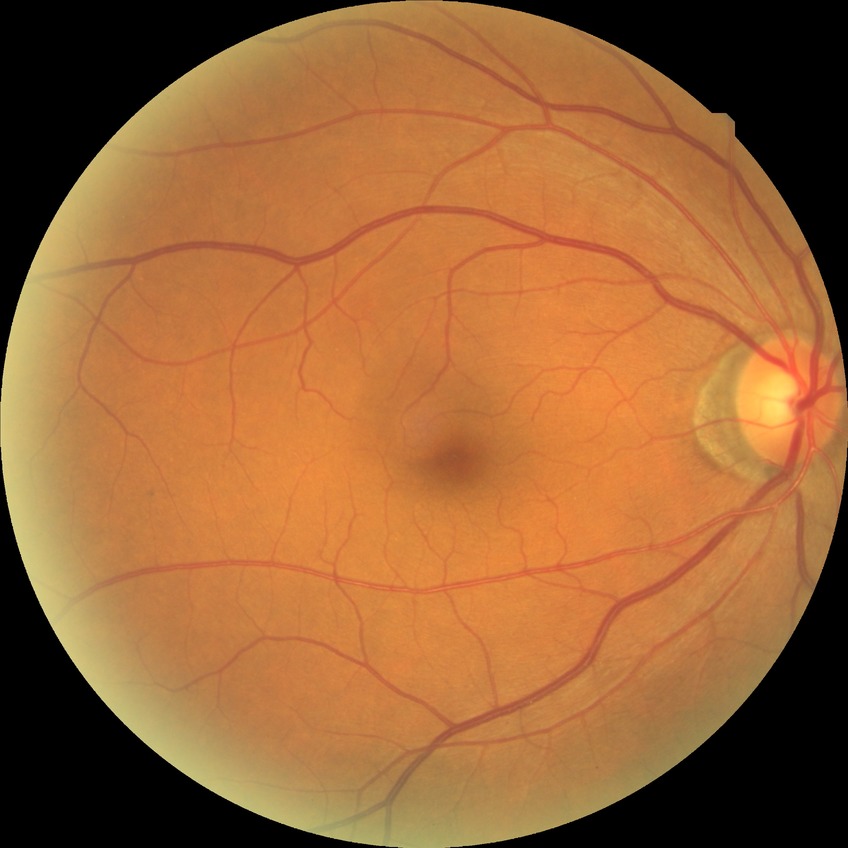
{
  "dr_impression": "negative for DR",
  "davis_grade": "NDR"
}